Wide-field contact fundus photograph of an infant · 1240x1240: 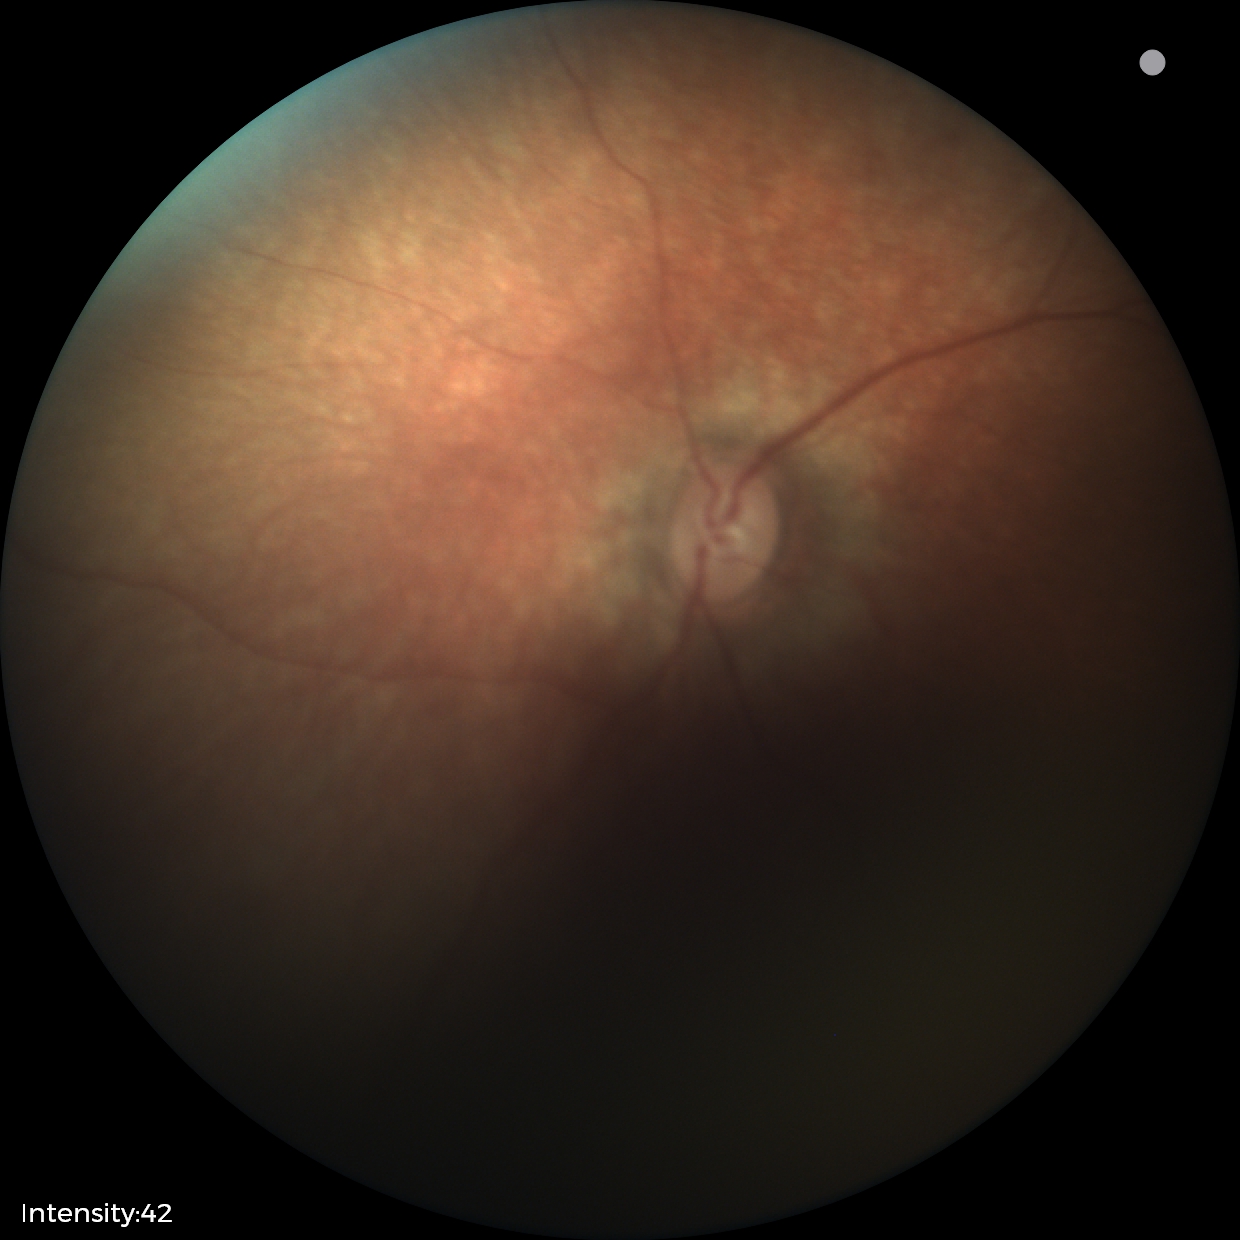
Normal screening examination.